2048 x 1536 pixels:
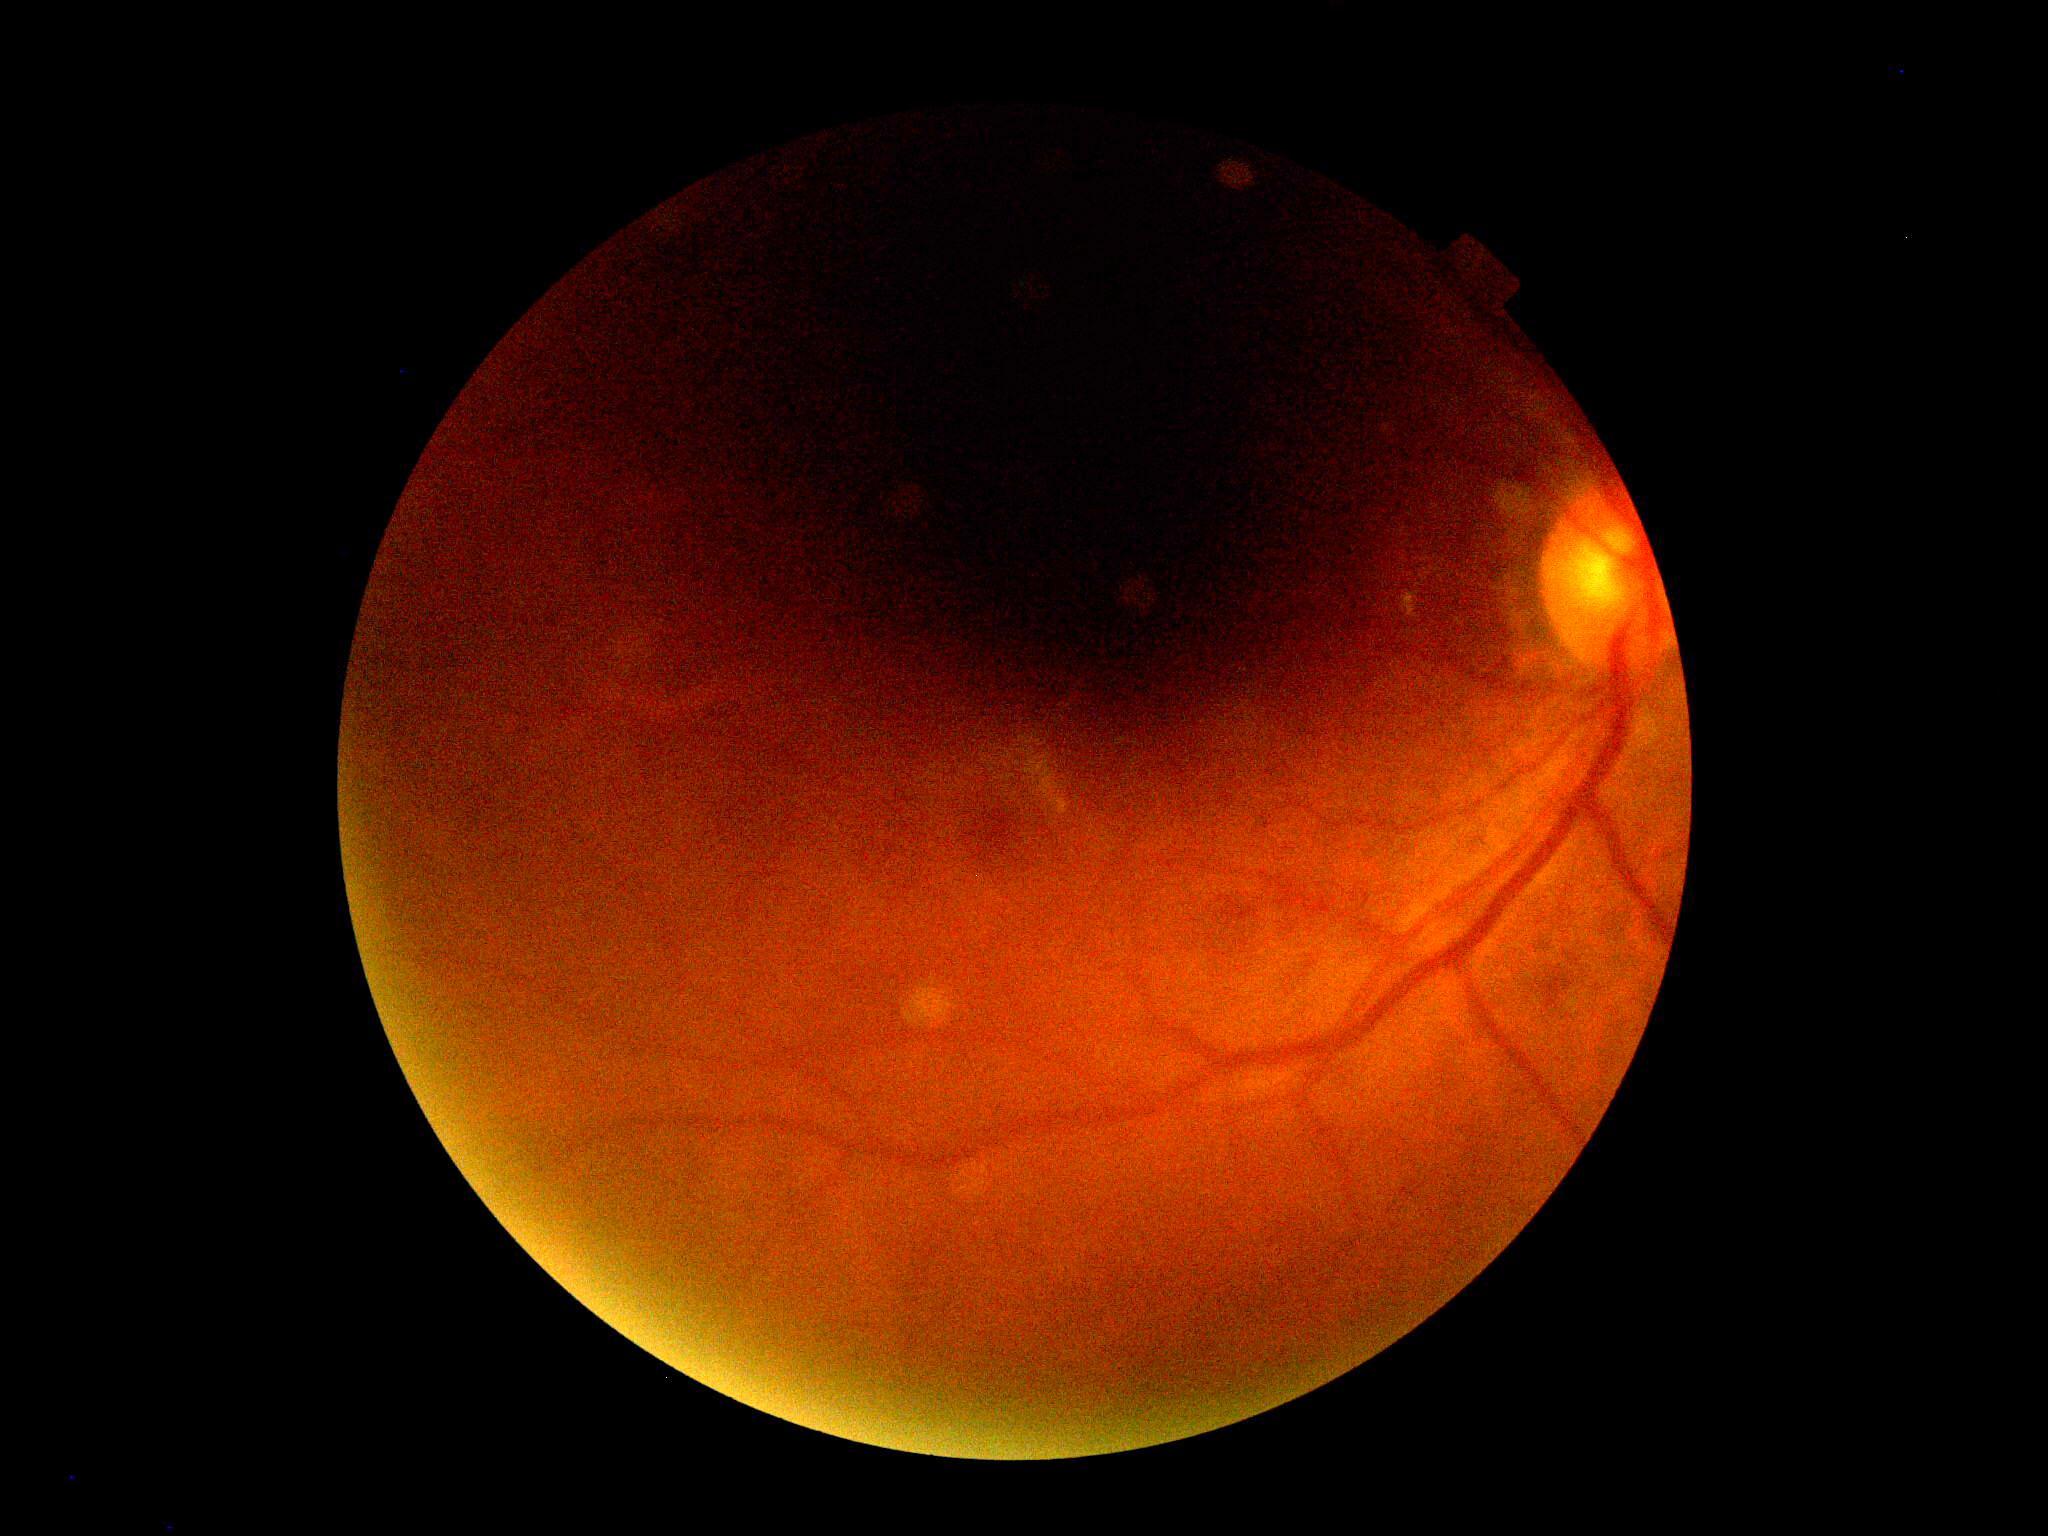 Diabetic retinopathy grade: ungradable due to poor image quality.